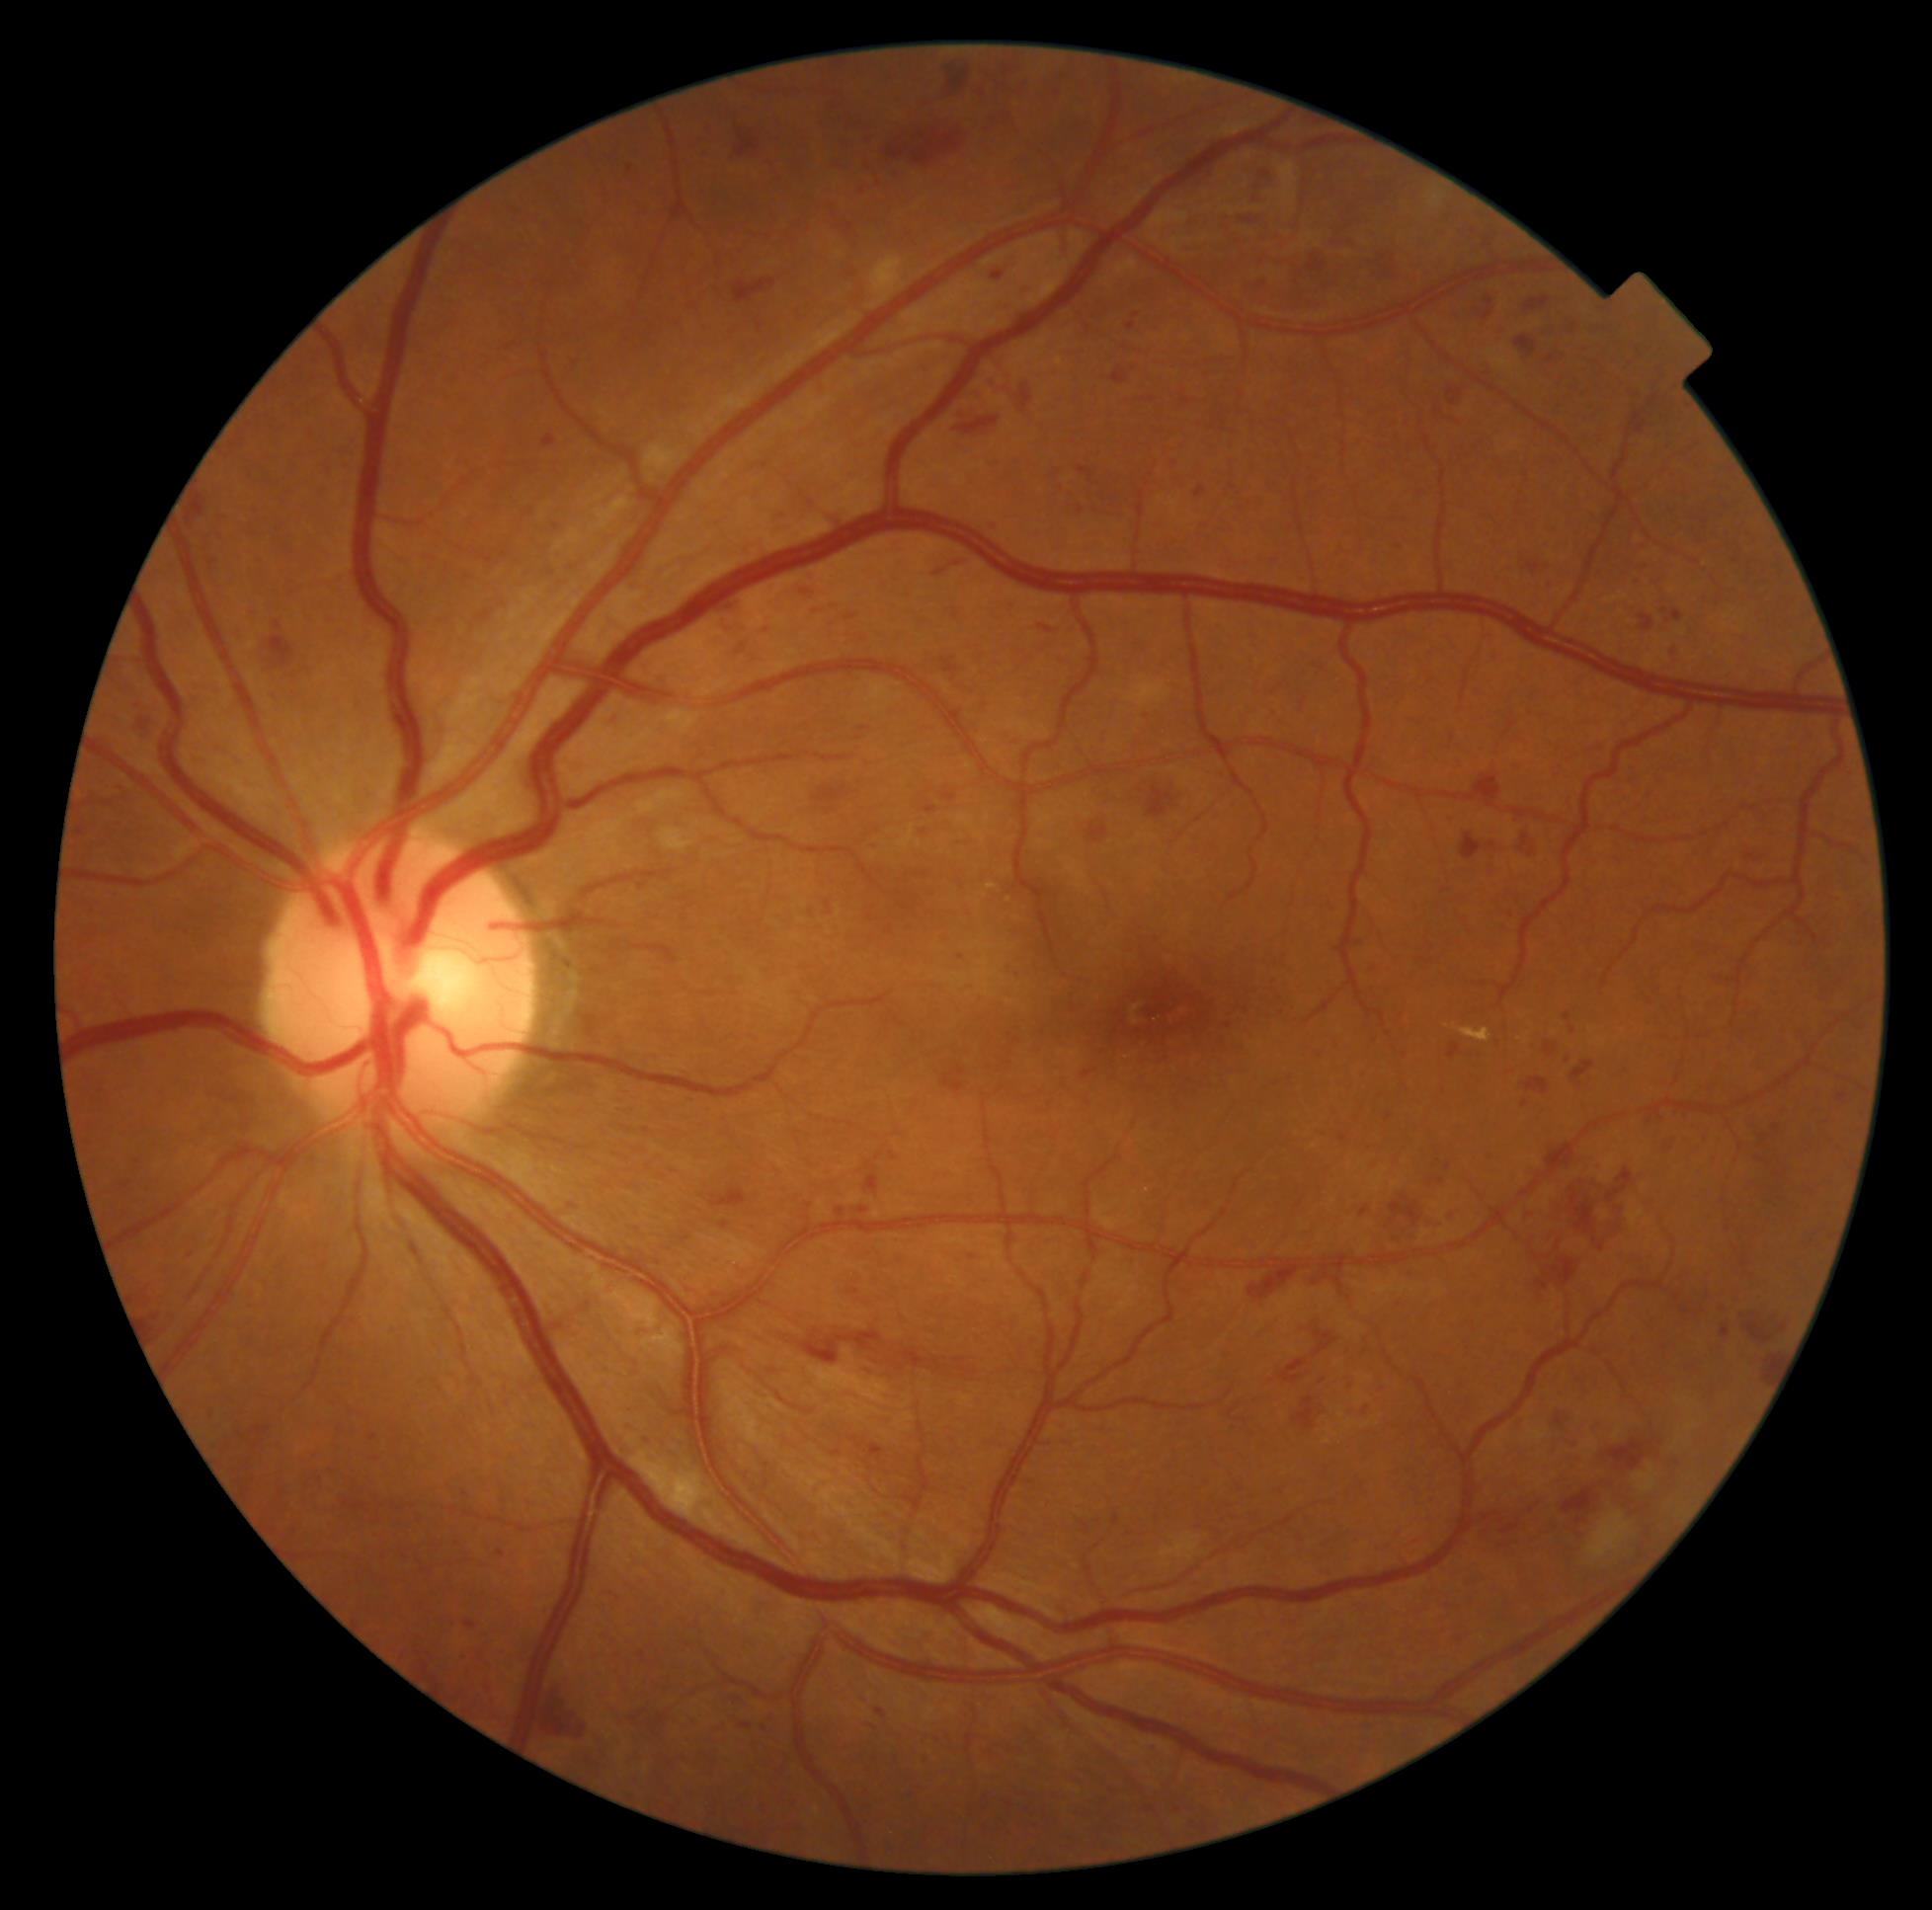
Diabetic retinopathy (DR) is grade 3 — more than 20 intraretinal hemorrhages in each of 4 quadrants, definite venous beading in 2 or more quadrants, or prominent intraretinal microvascular abnormalities in 1 or more quadrants, with no signs of proliferative retinopathy.